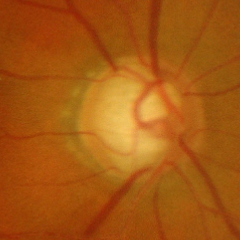 Q: What is the glaucoma diagnosis?
A: Advanced-stage glaucoma.